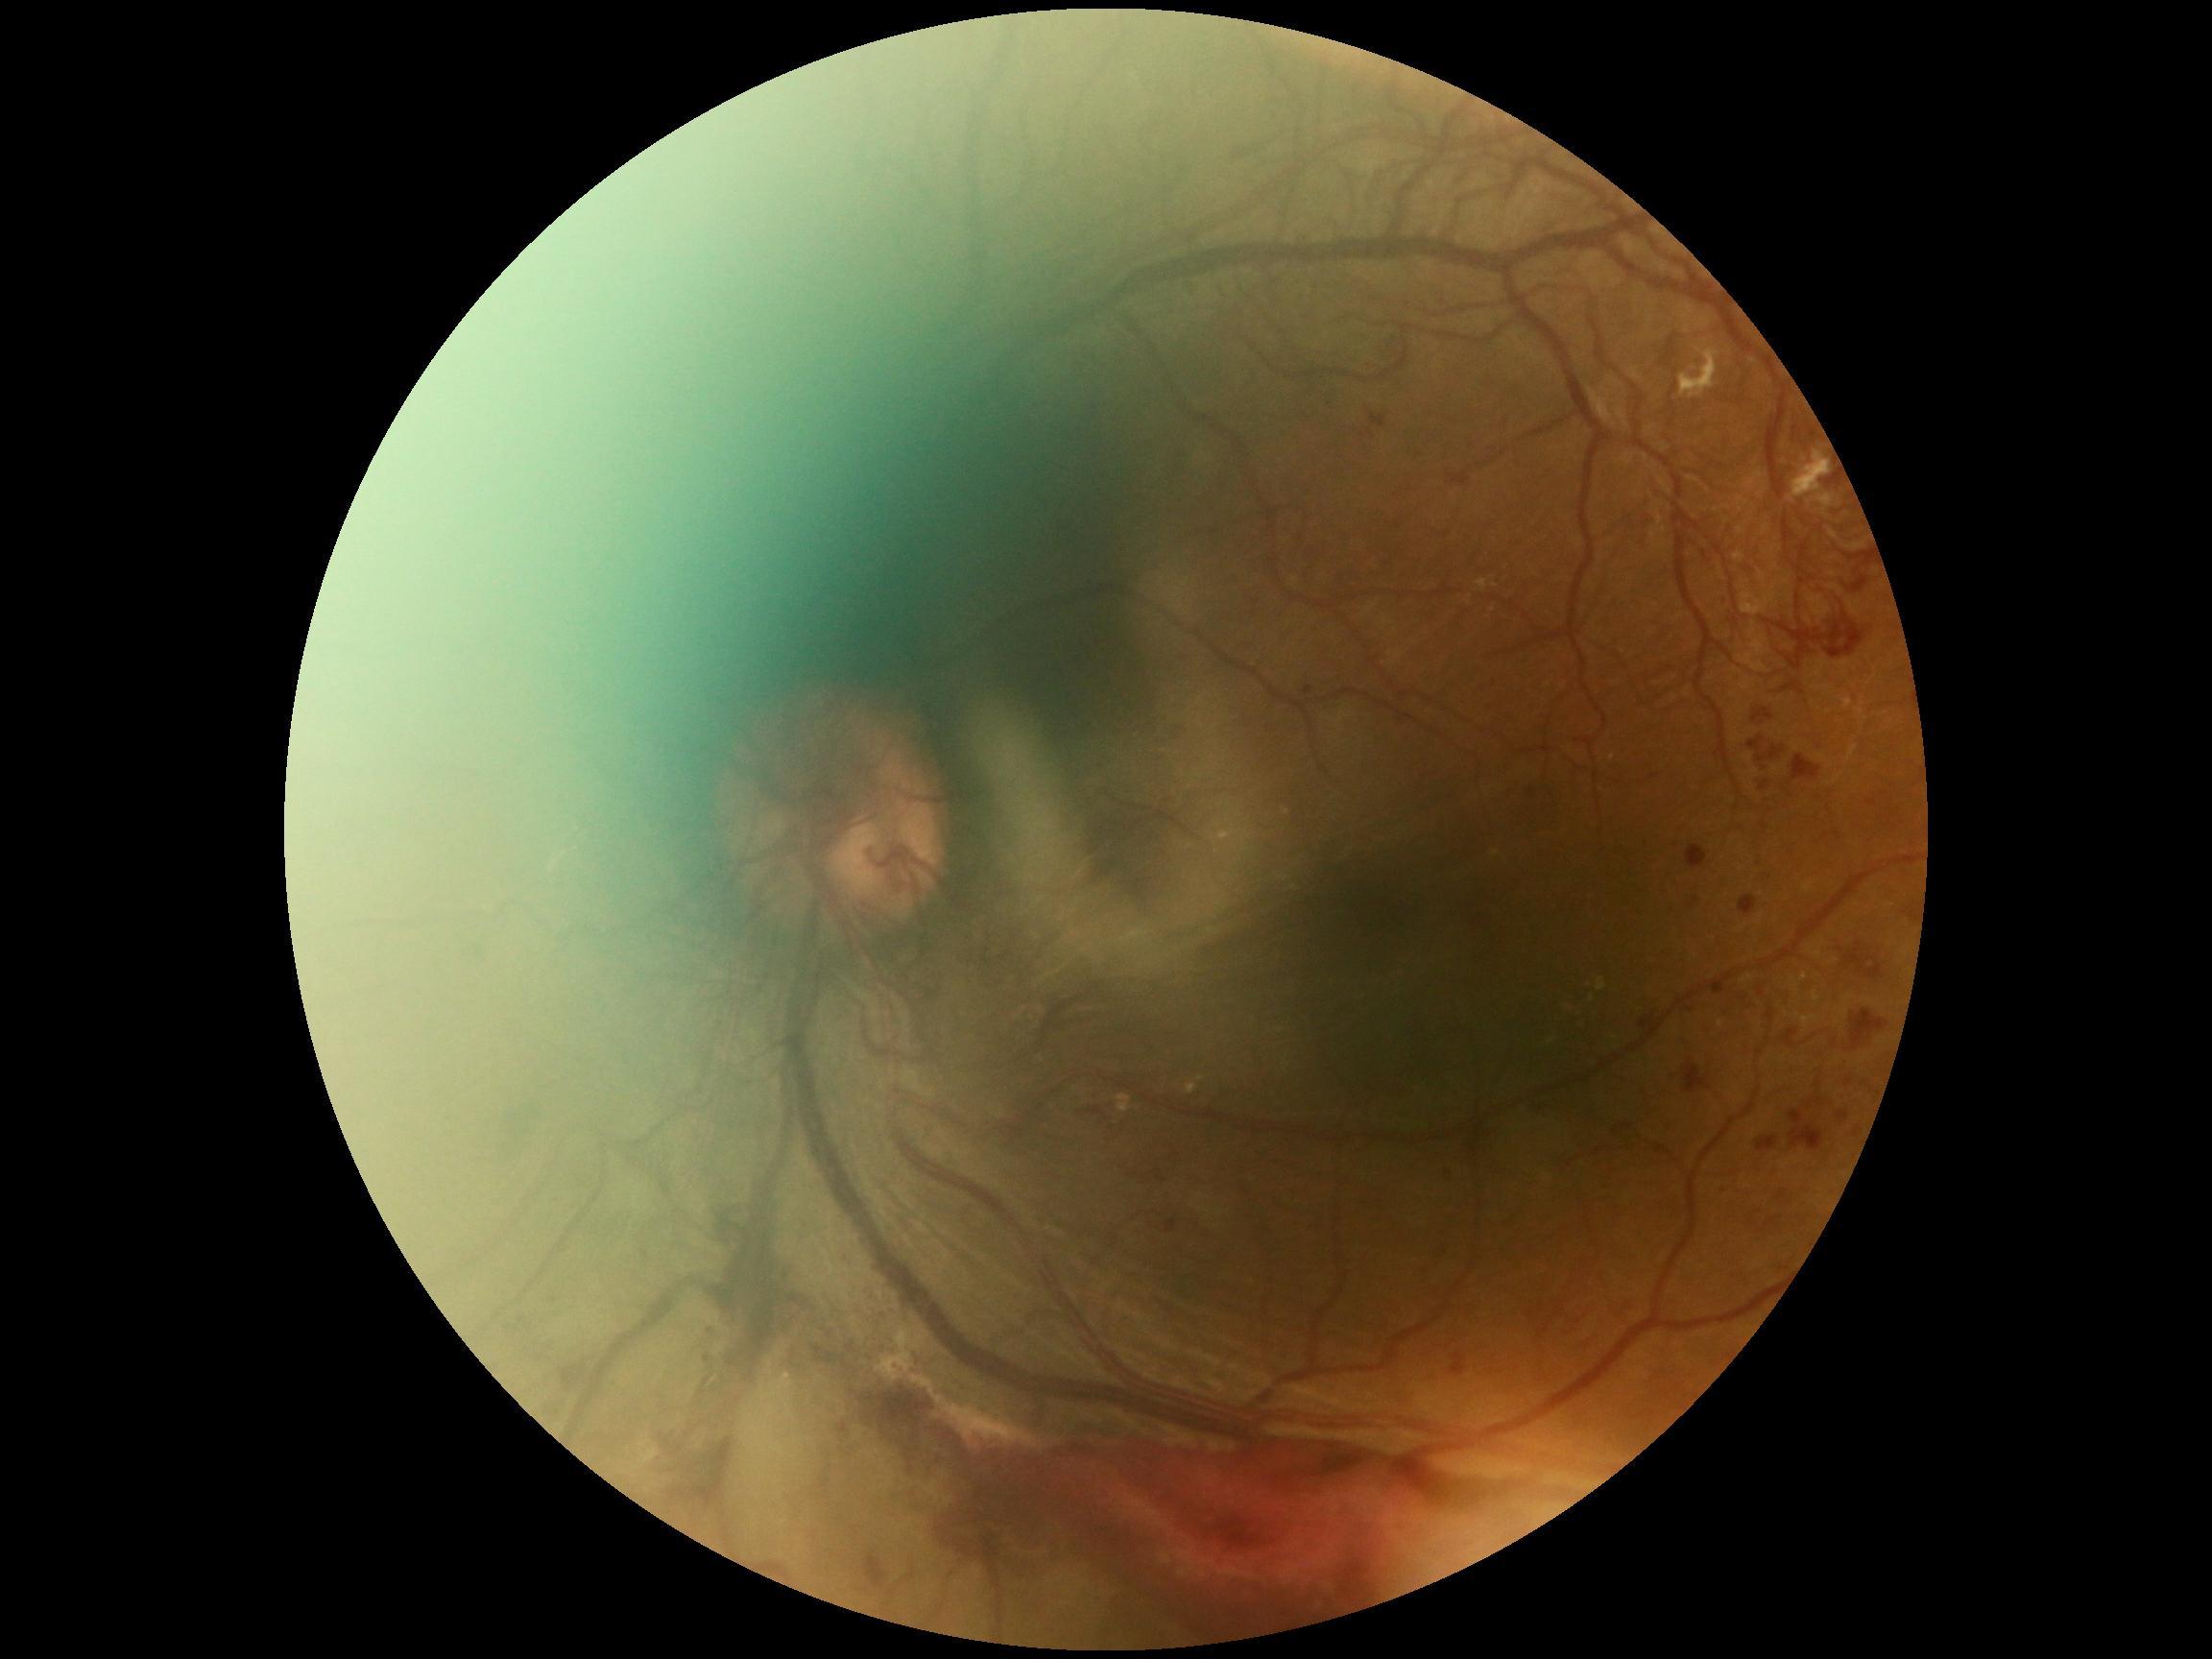 DR stage=grade 4 (PDR).